45-degree field of view. Retinal fundus photograph: 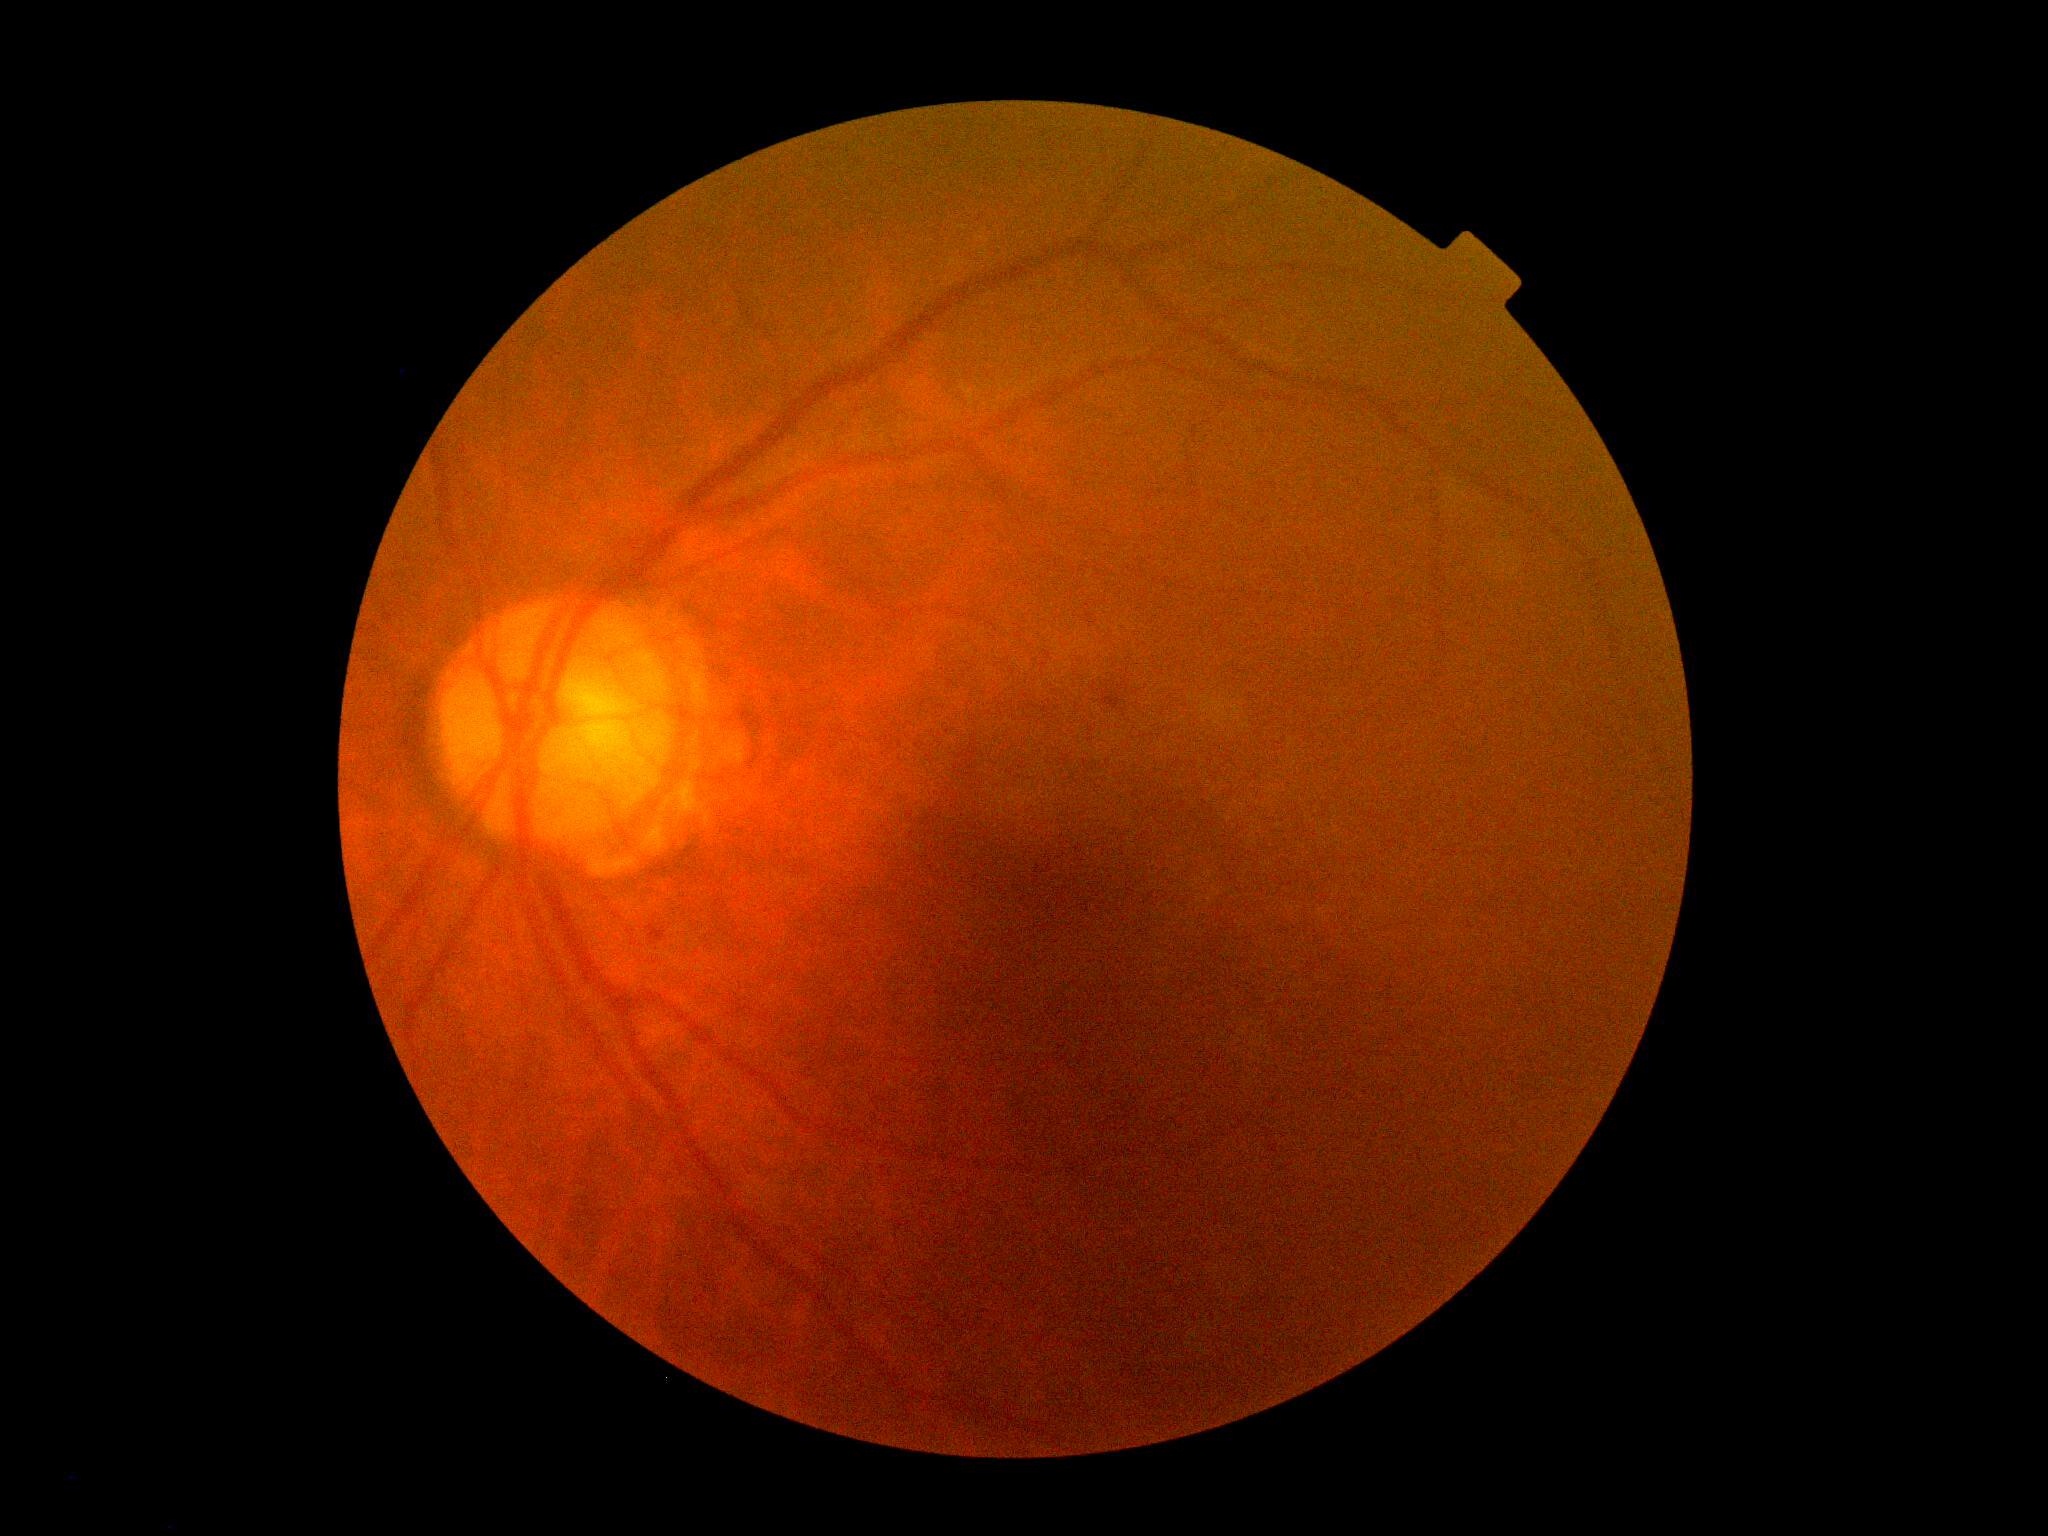 {
  "dr_grade": "grade 2 (moderate NPDR)"
}